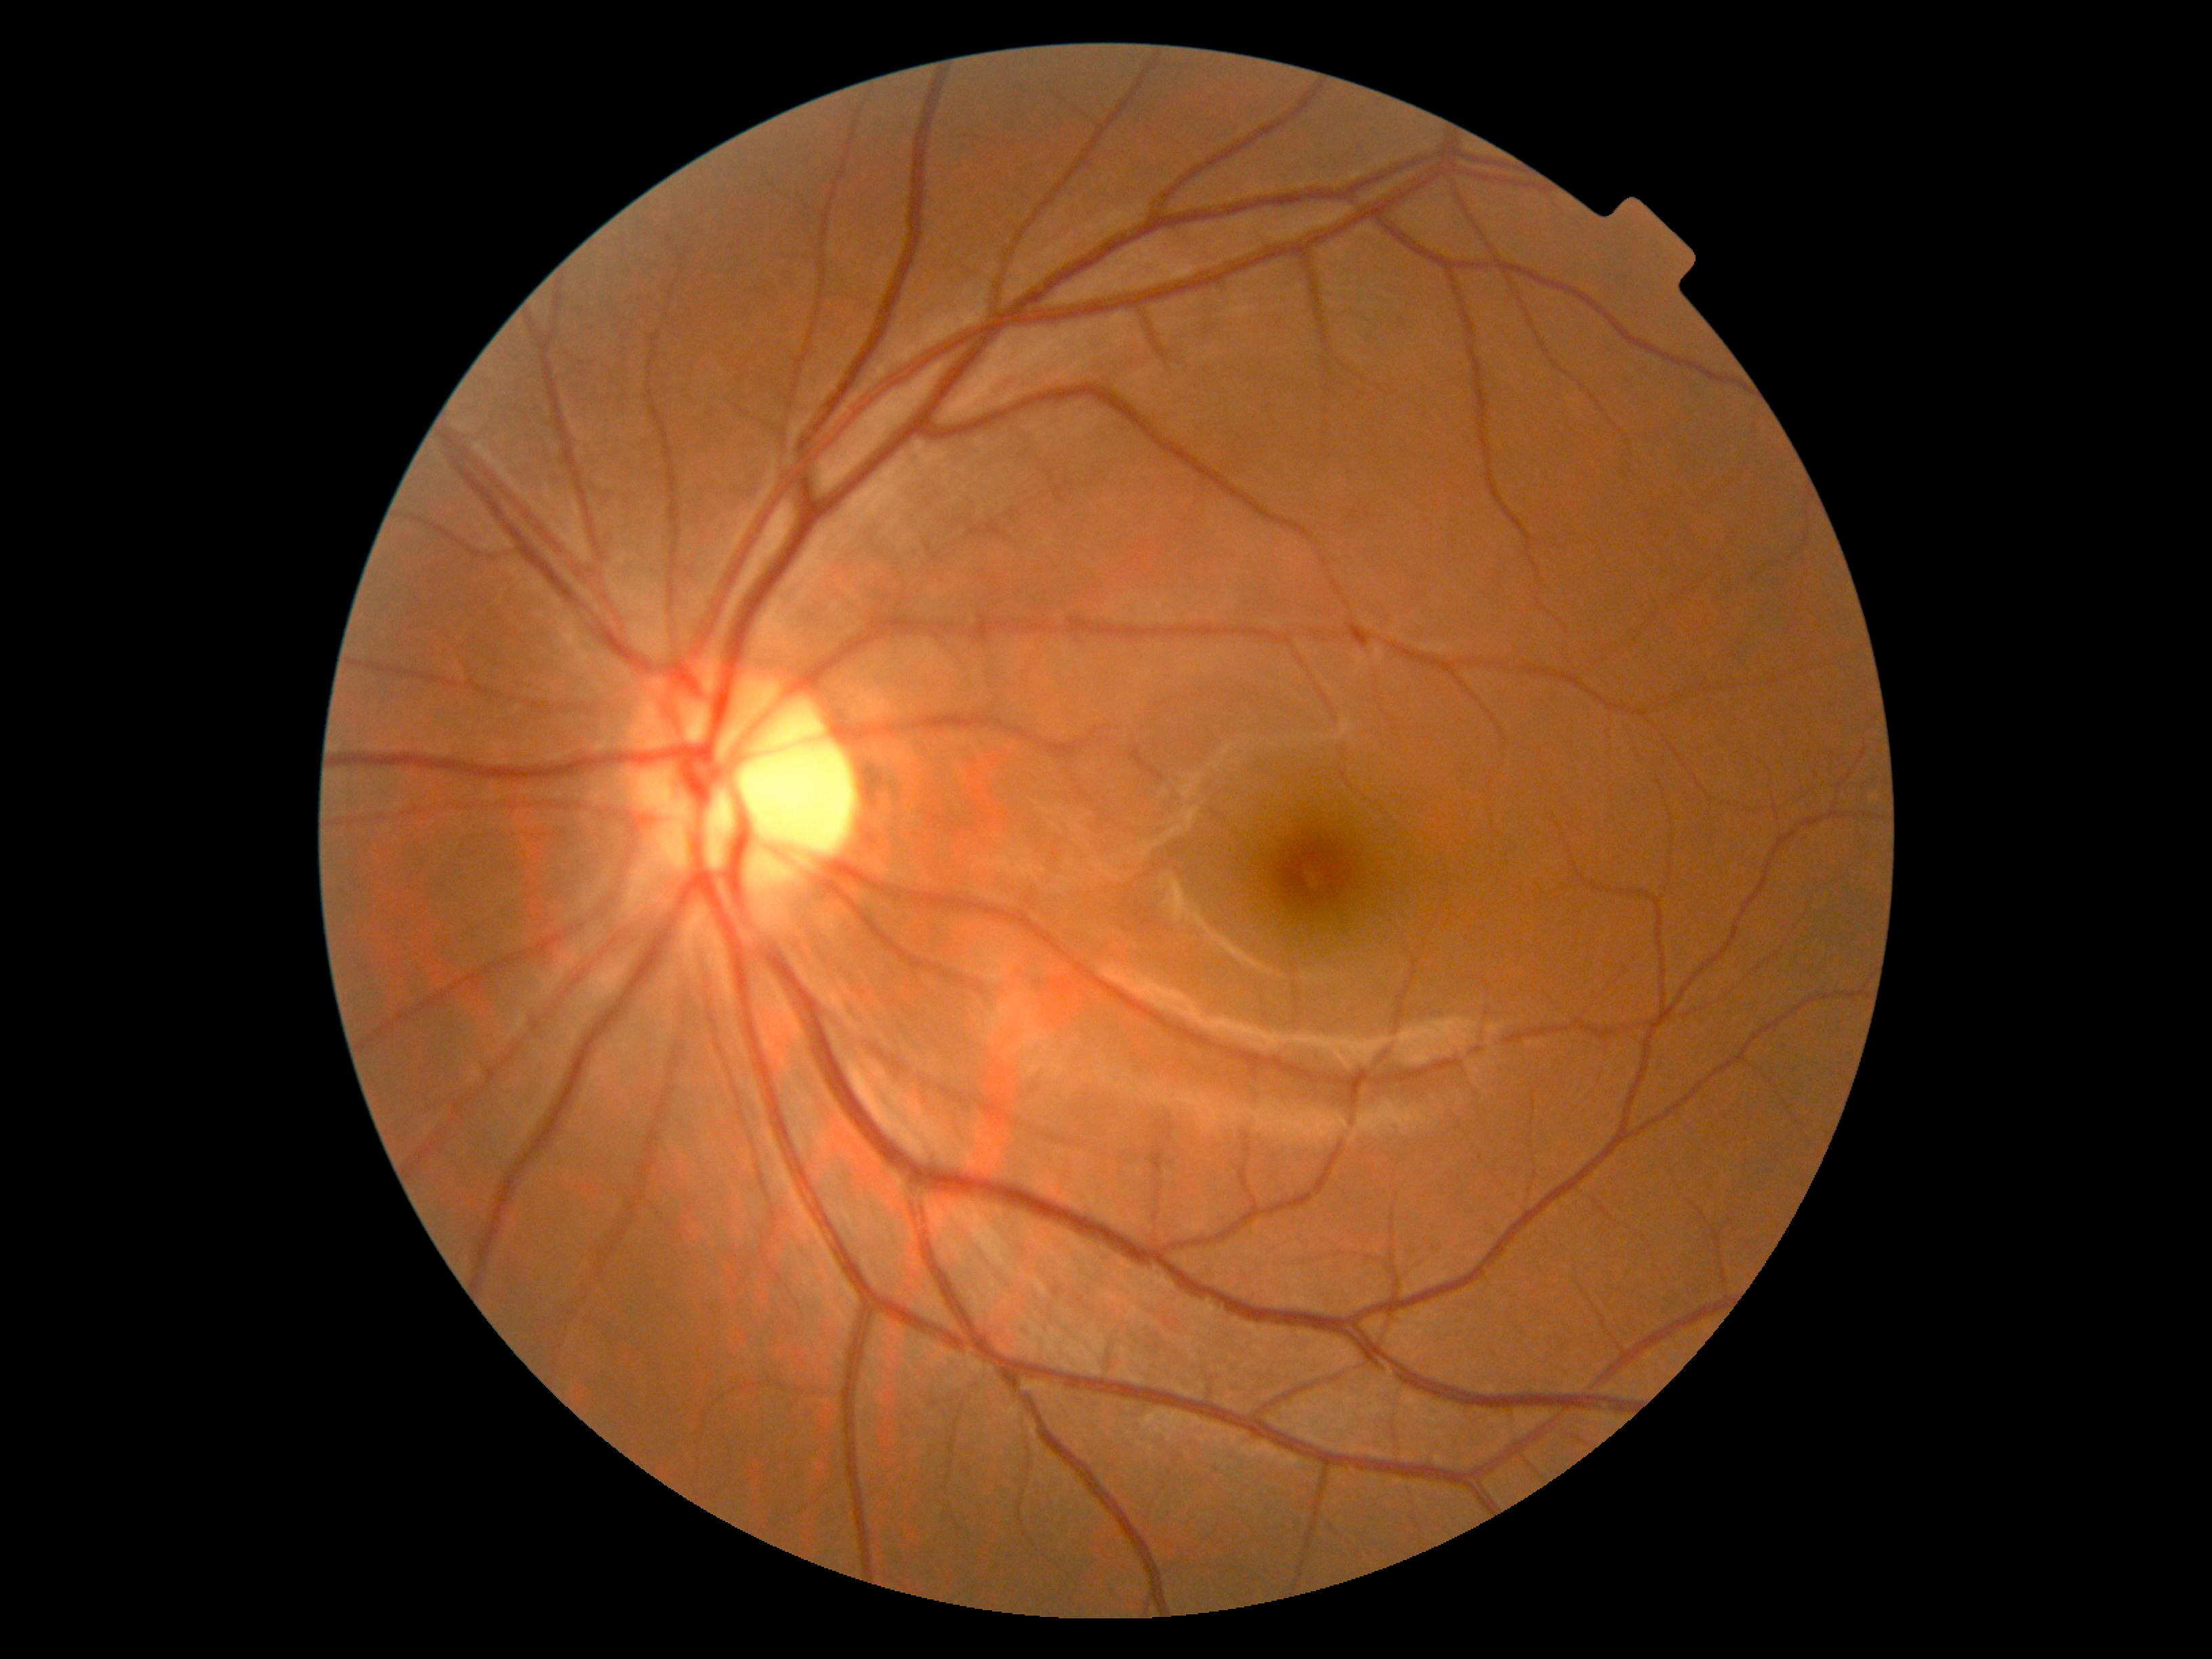
DR severity is no apparent diabetic retinopathy (grade 0).